2352x1568px.
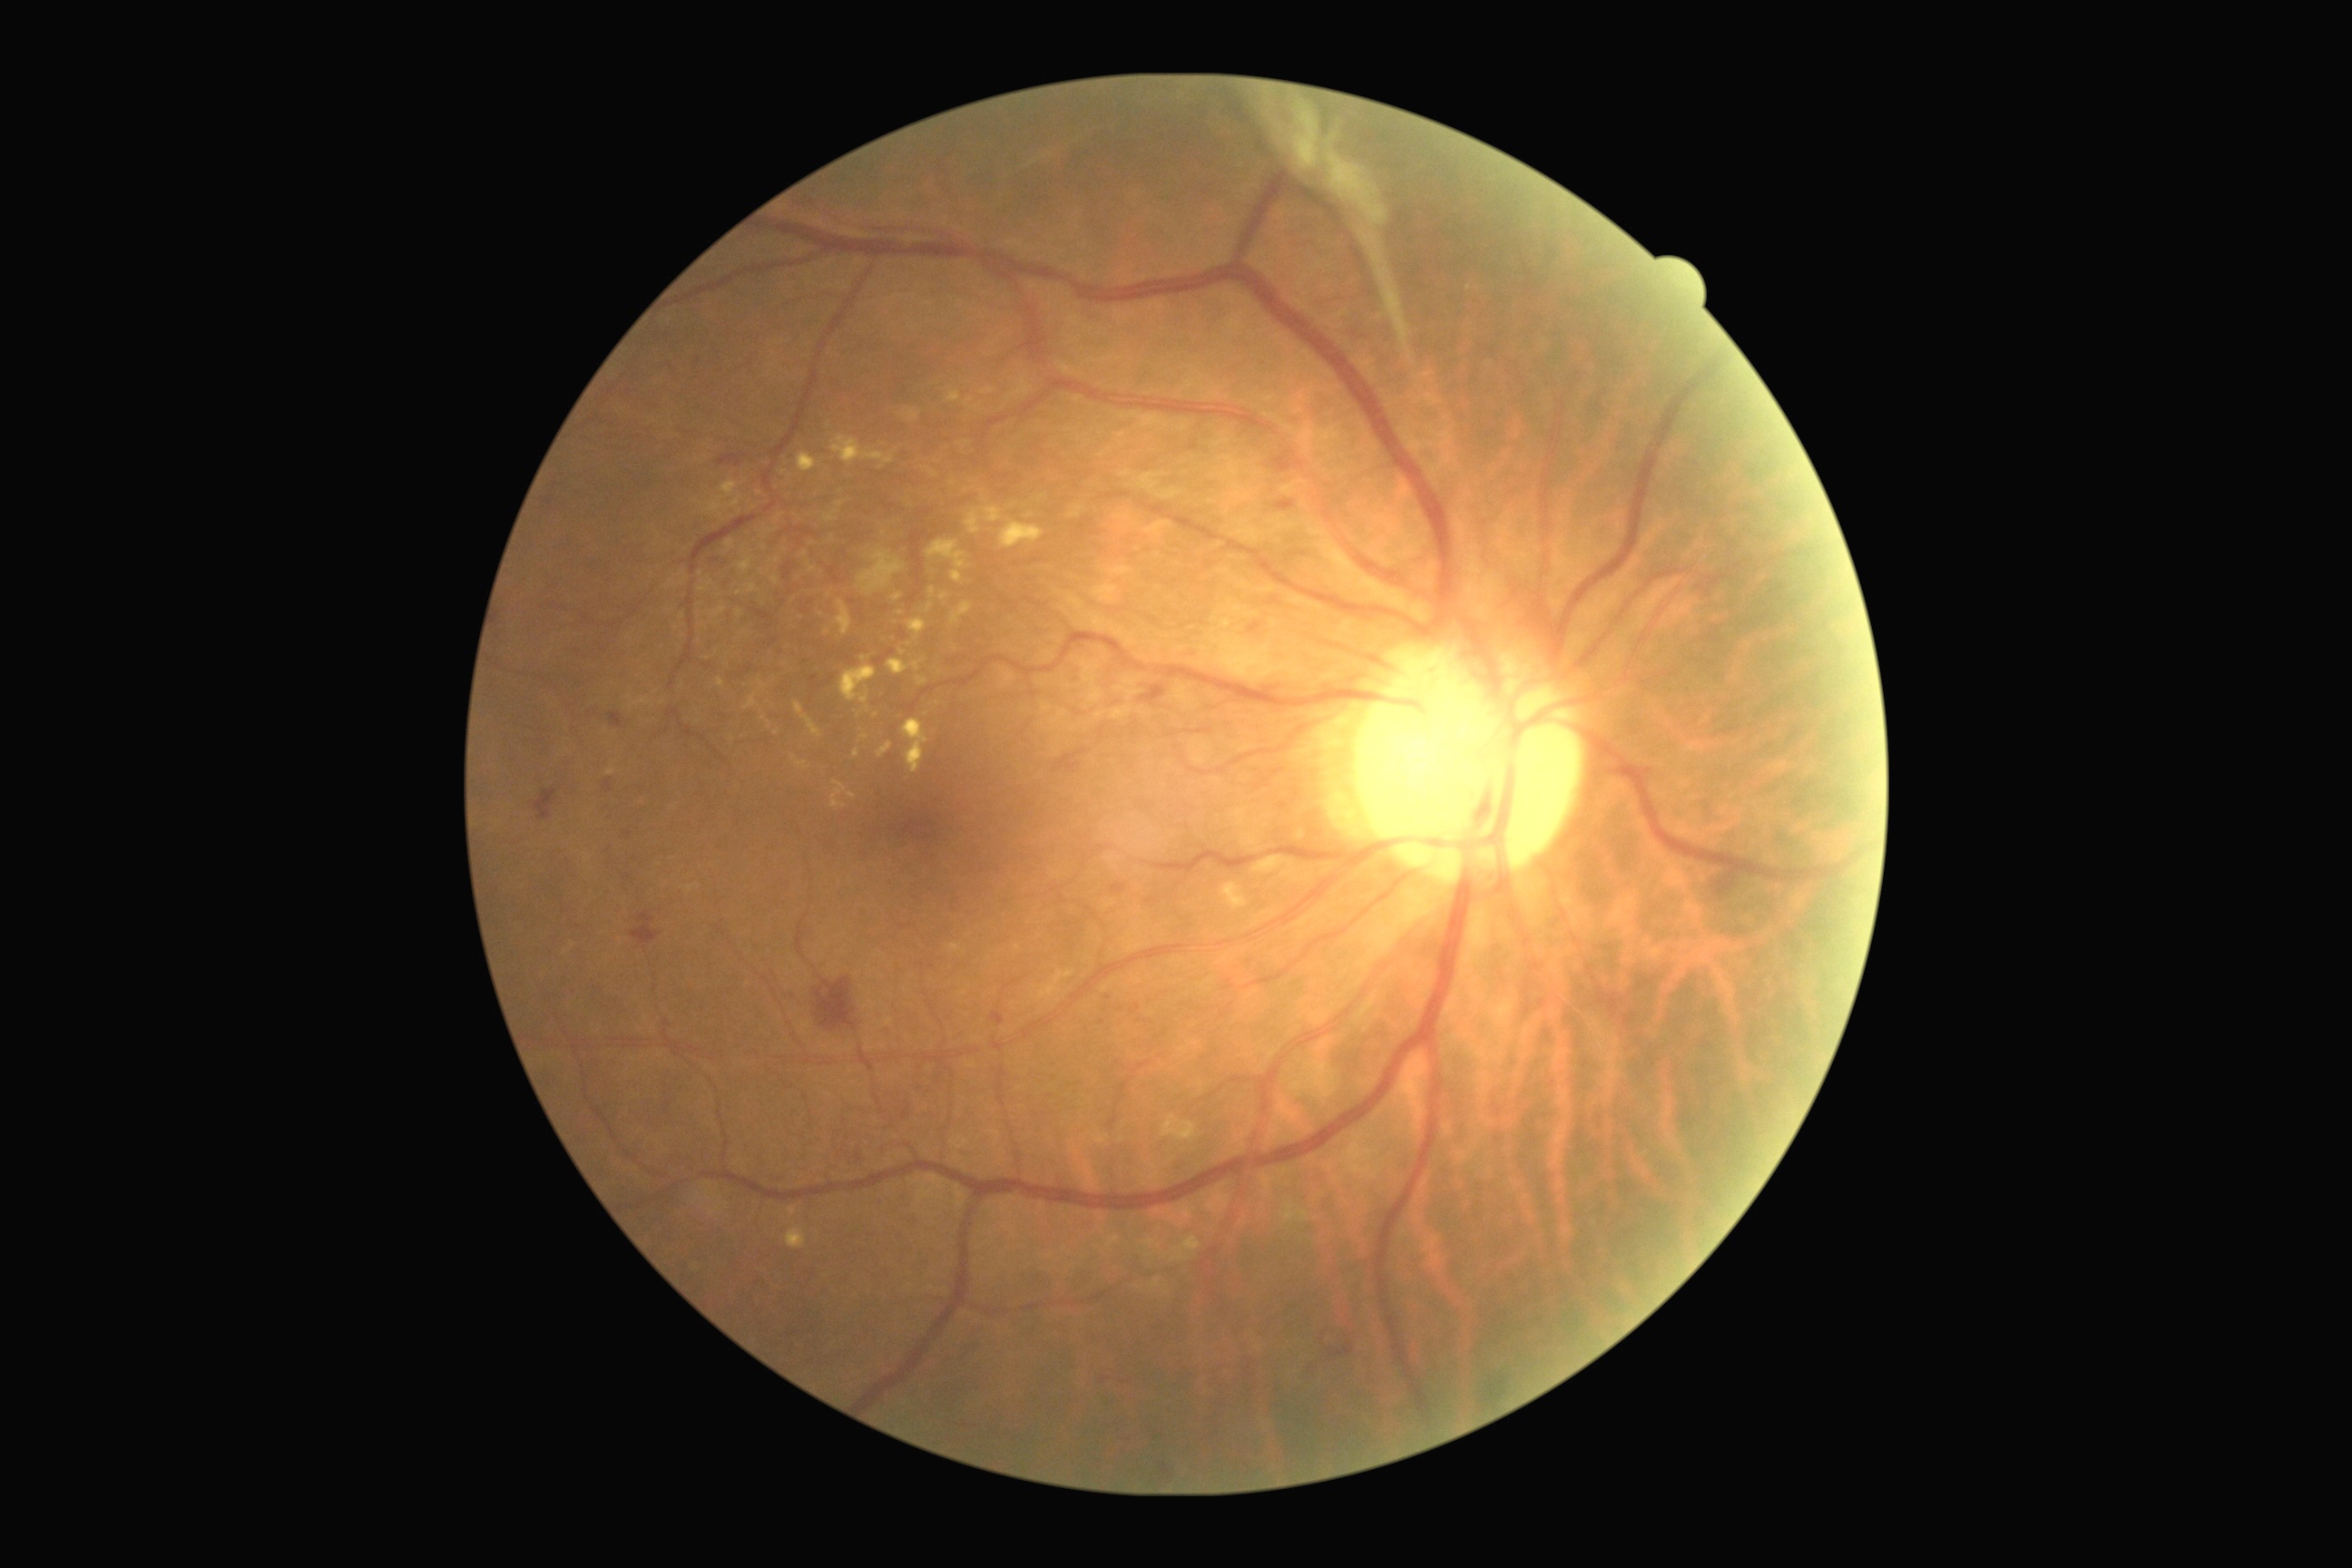

Diabetic retinopathy (DR) is proliferative diabetic retinopathy (grade 4)
Lesions identified (partial list):
hard exudates (EXs) (subset): (left=709, top=496, right=741, bottom=516) | (left=854, top=749, right=859, bottom=760) | (left=1026, top=513, right=1034, bottom=520) | (left=738, top=609, right=745, bottom=618) | (left=877, top=743, right=894, bottom=760) | (left=789, top=1208, right=798, bottom=1217) | (left=981, top=387, right=995, bottom=395) | (left=926, top=540, right=968, bottom=583) | (left=745, top=583, right=758, bottom=594) | (left=794, top=701, right=821, bottom=738) | (left=894, top=594, right=903, bottom=602) | (left=830, top=781, right=847, bottom=808) | (left=848, top=794, right=858, bottom=799) | (left=745, top=692, right=758, bottom=710) | (left=966, top=511, right=981, bottom=534)
EXs (small, approximate centers) near pt(902, 613) | pt(794, 758) | pt(952, 483) | pt(770, 531) | pt(764, 548)